Axial length (AL): 21.79 mm. Fundus photo. Captured without pupil dilation. 30° FOV. 2212x1661px. Female. Intraocular pressure (IOP): 12 mmHg:
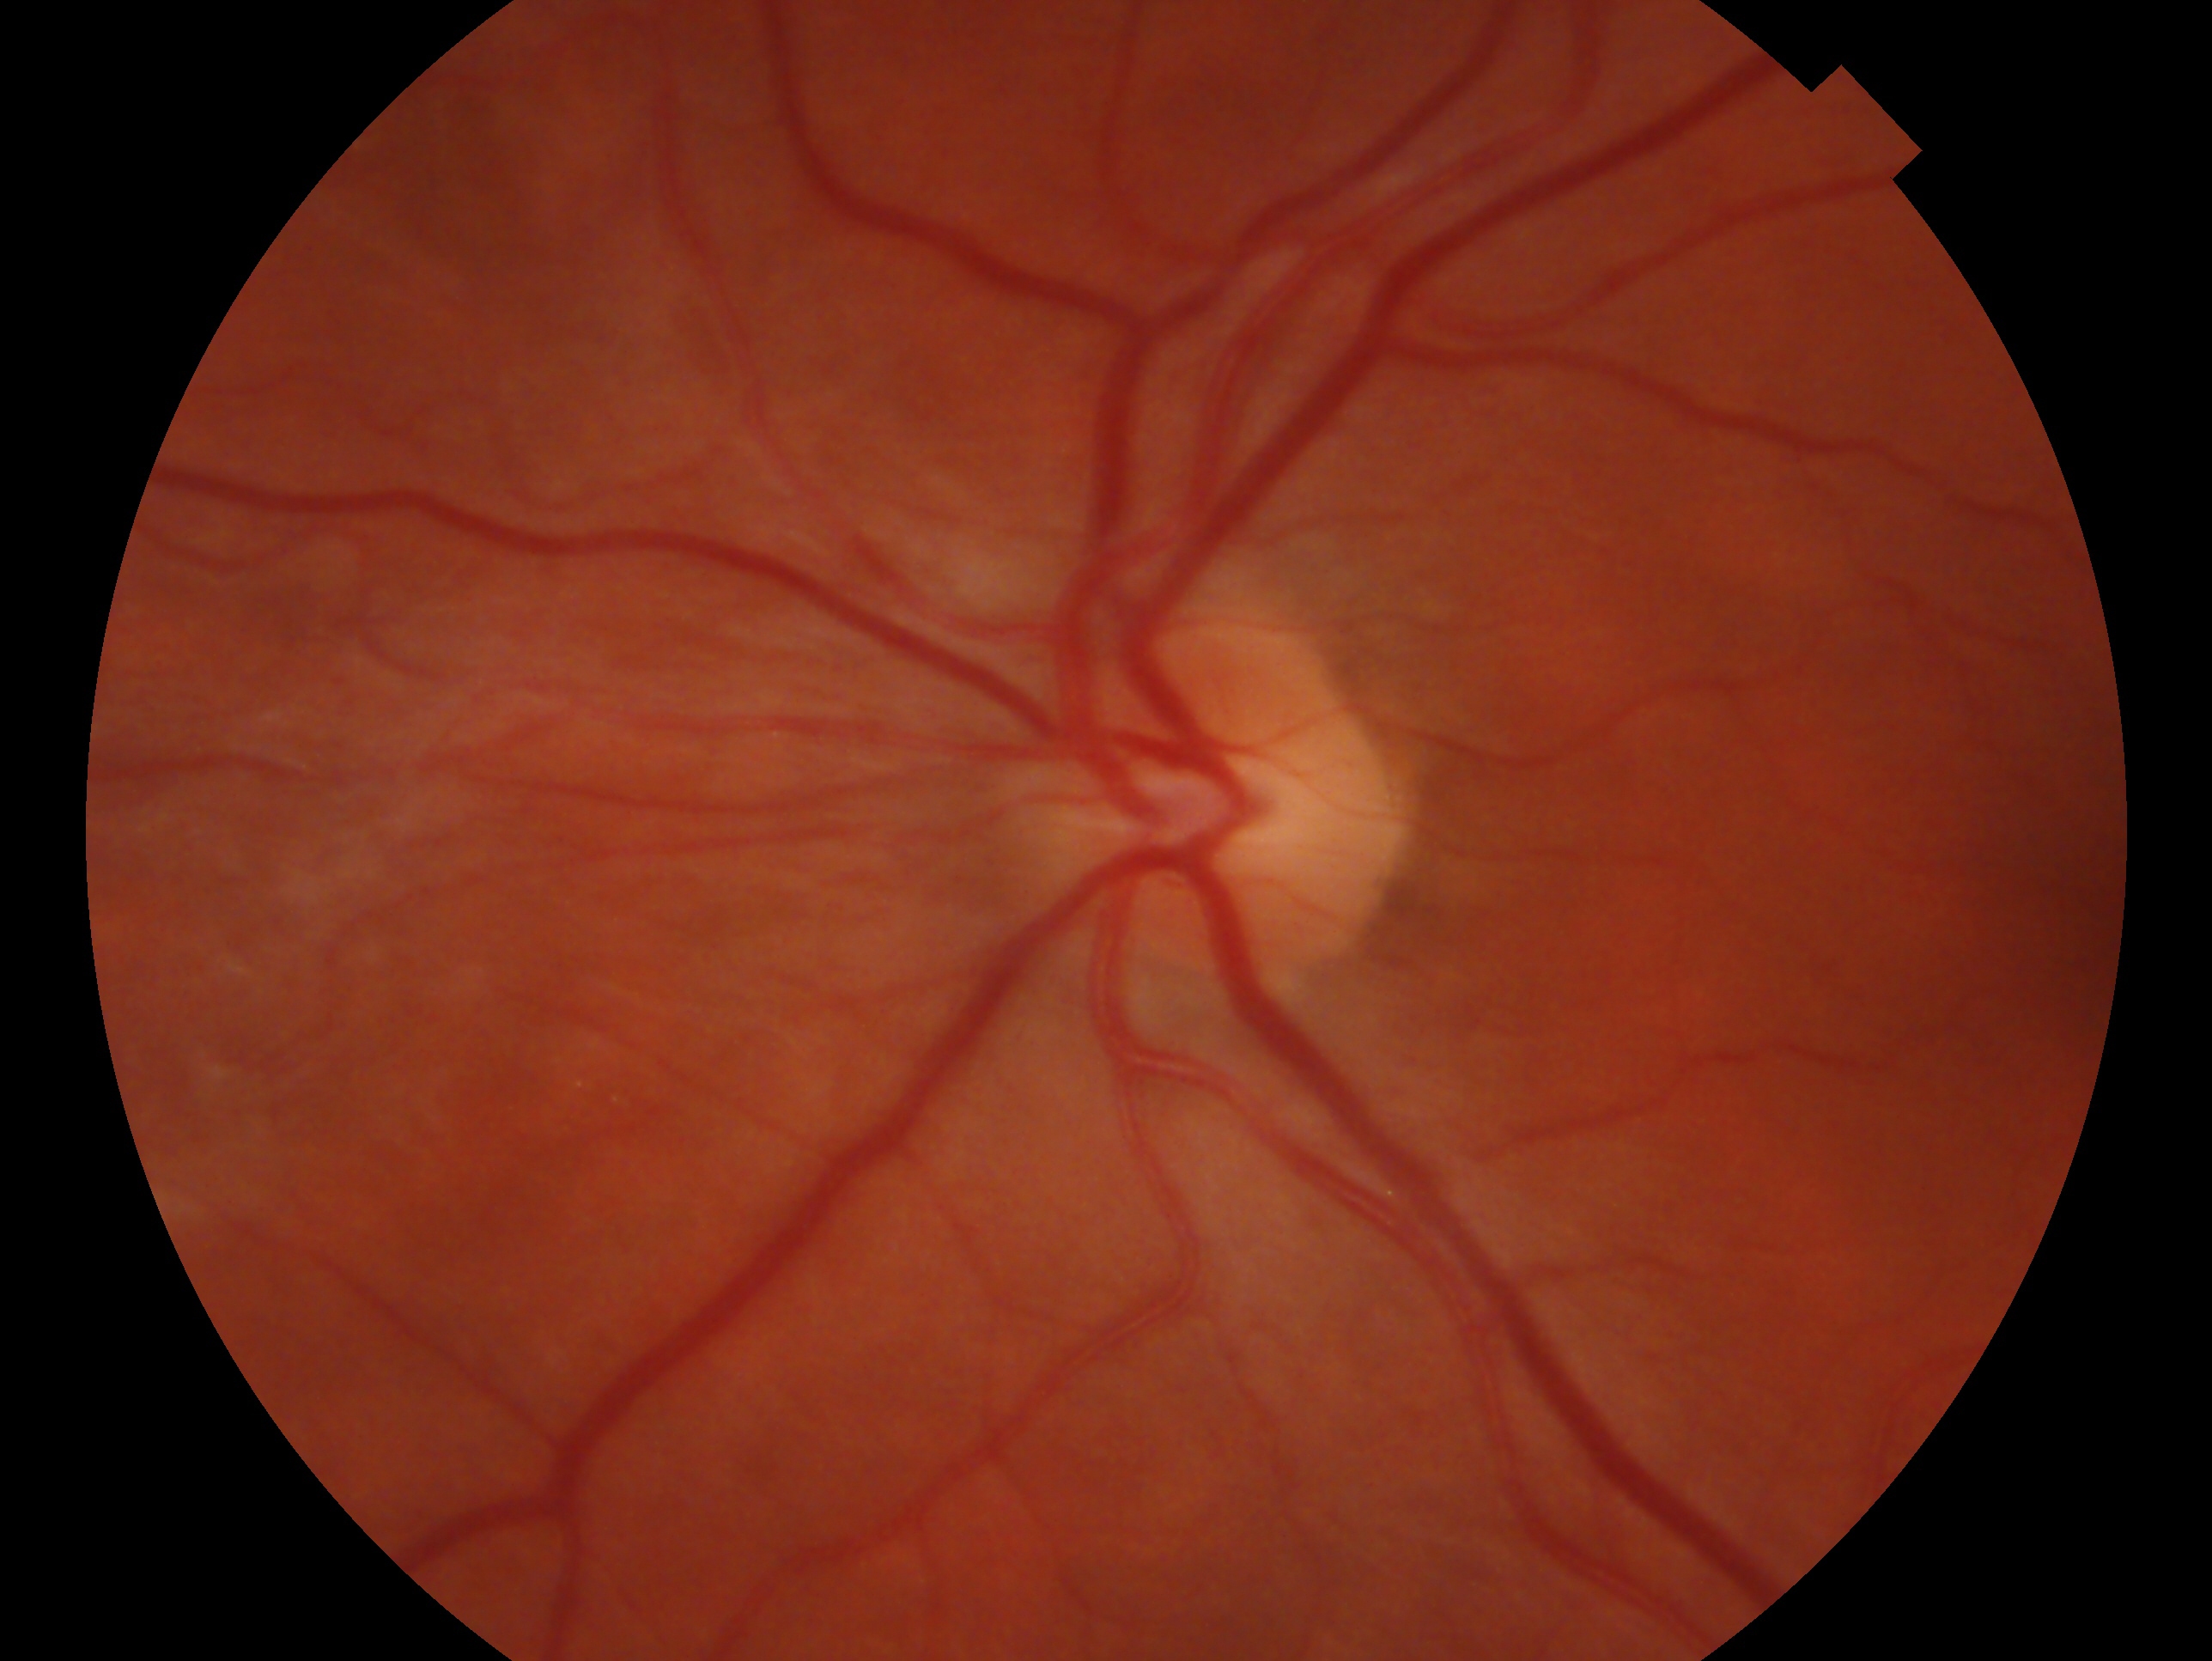
This is the left eye. Impression: no glaucoma — no clinical evidence of glaucoma in this eye.